Color fundus photograph. Image size 1659x2212 — 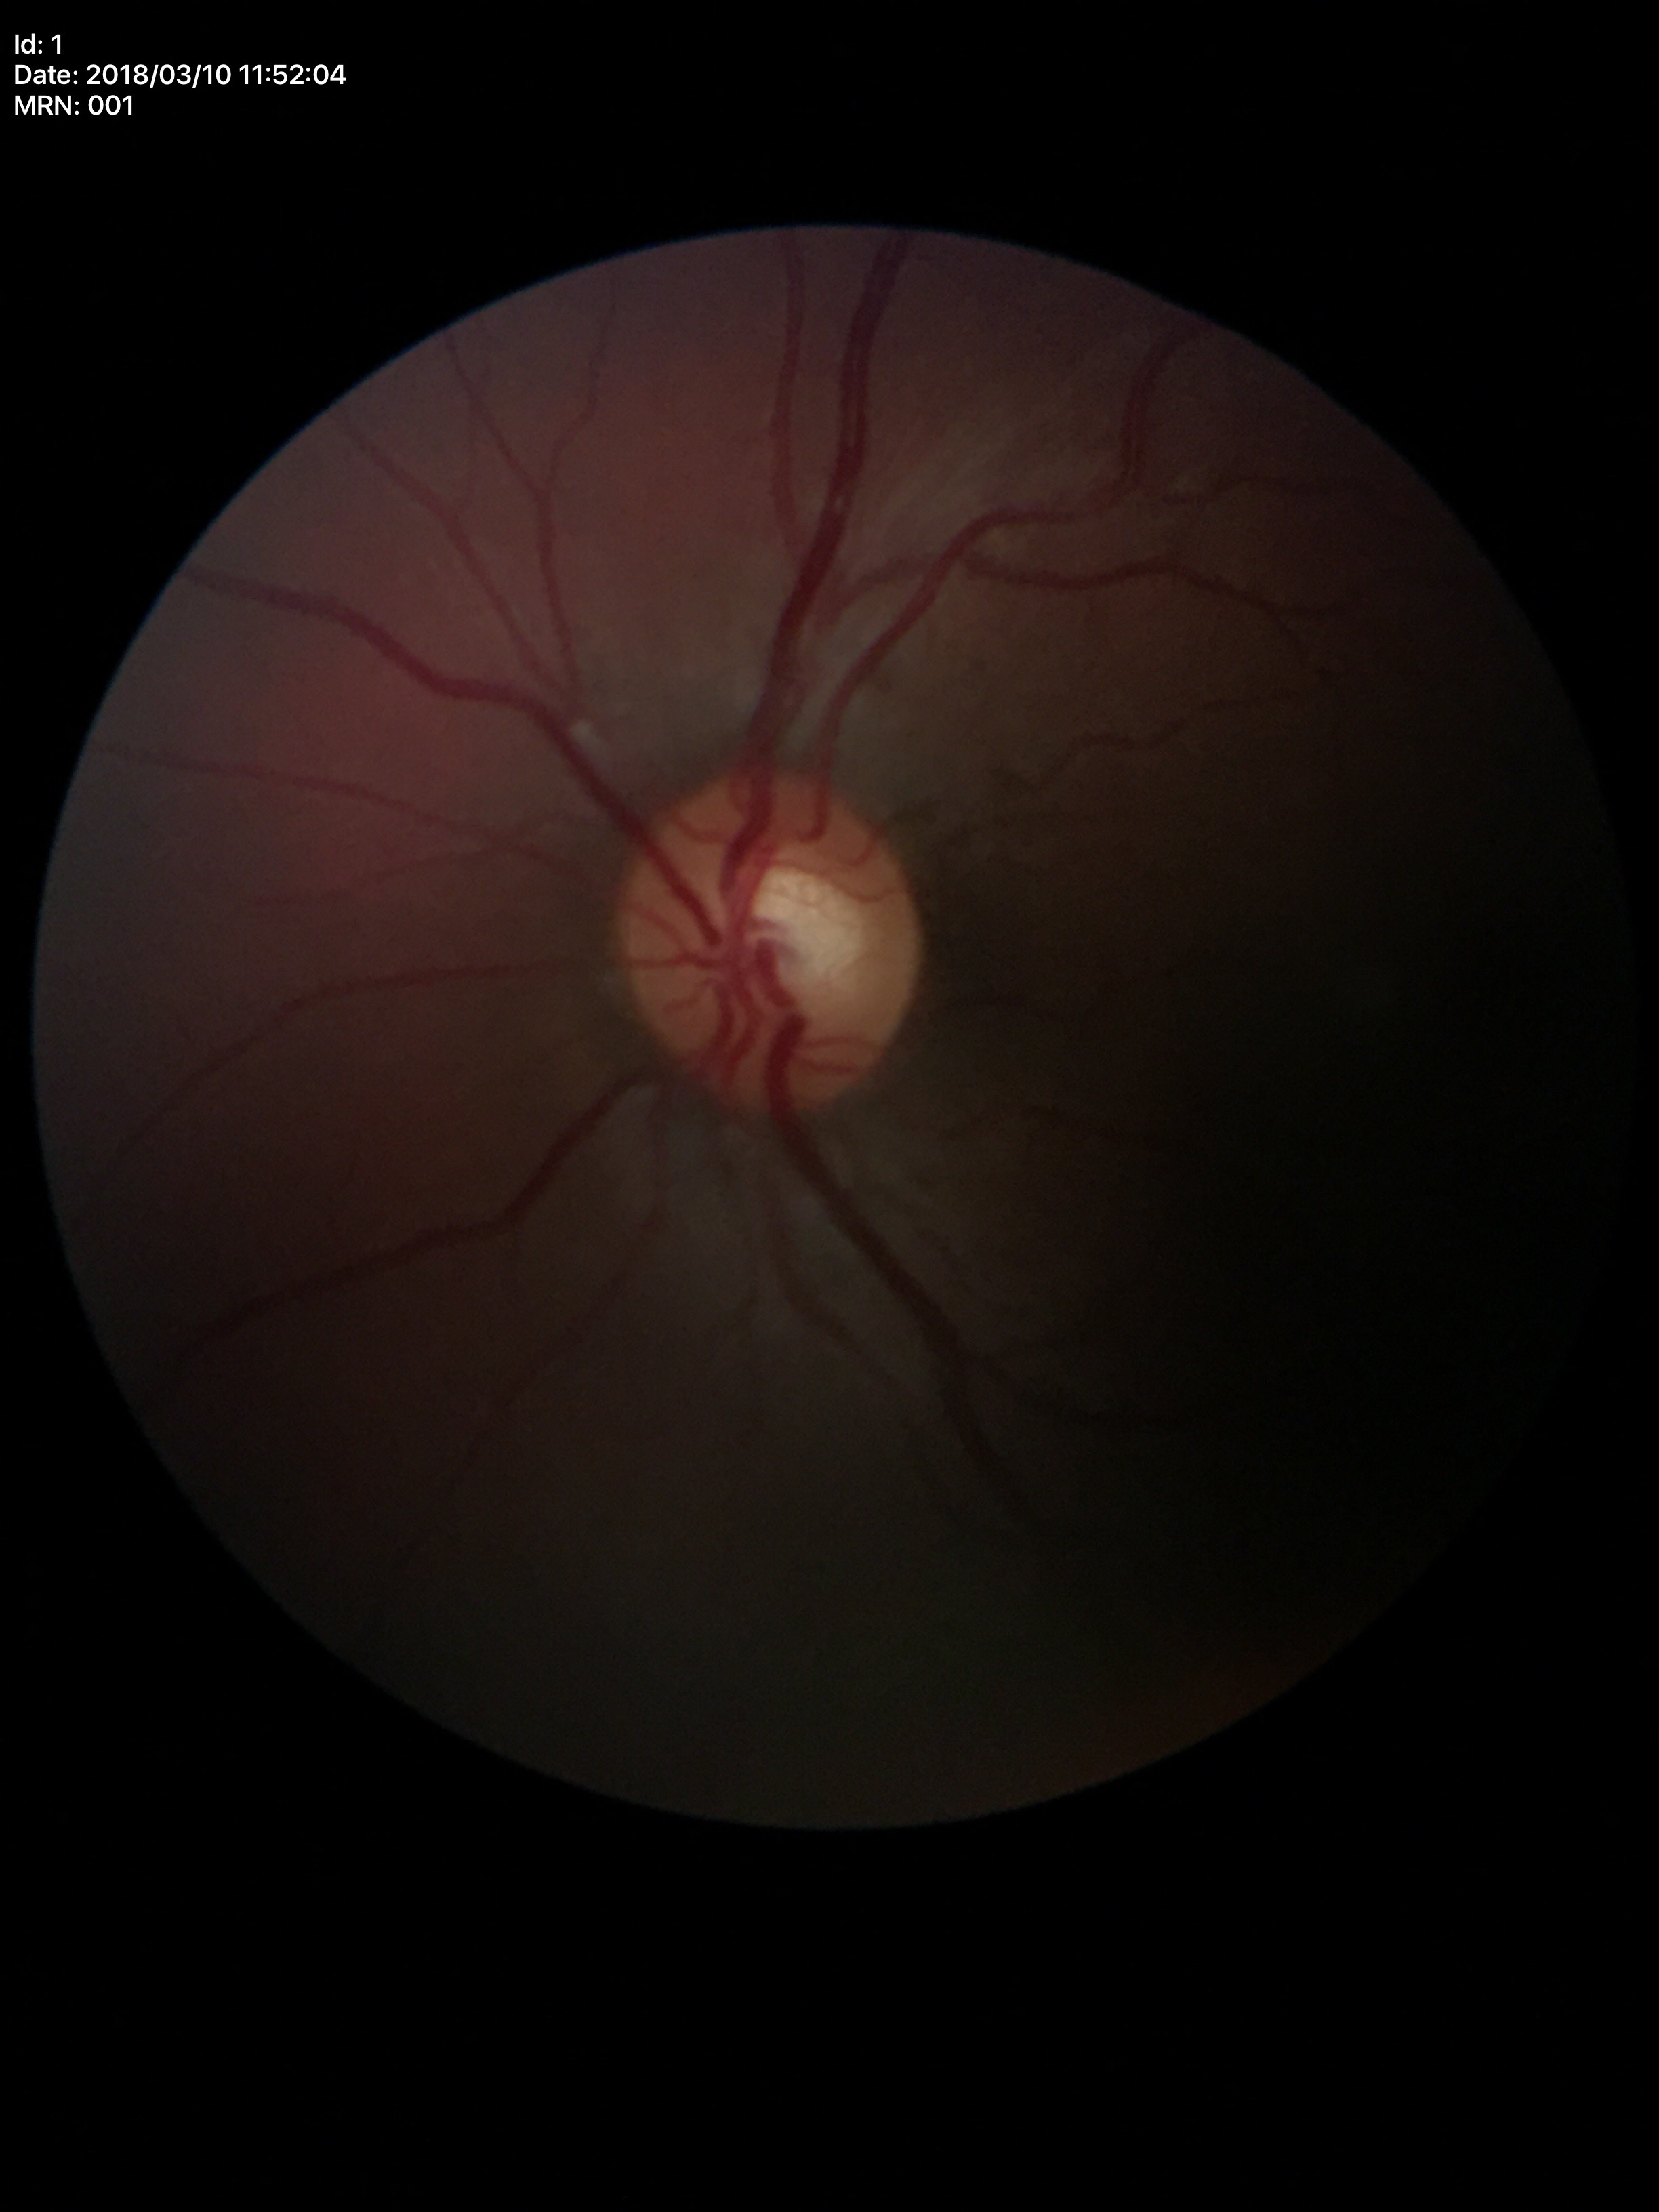
Horizontal CDR (HCDR) is 0.50. Area C/D ratio (ACDR) is 0.25. No signs of glaucoma (unanimous normal call). Vertical CDR (VCDR) of 0.49.